CFP — 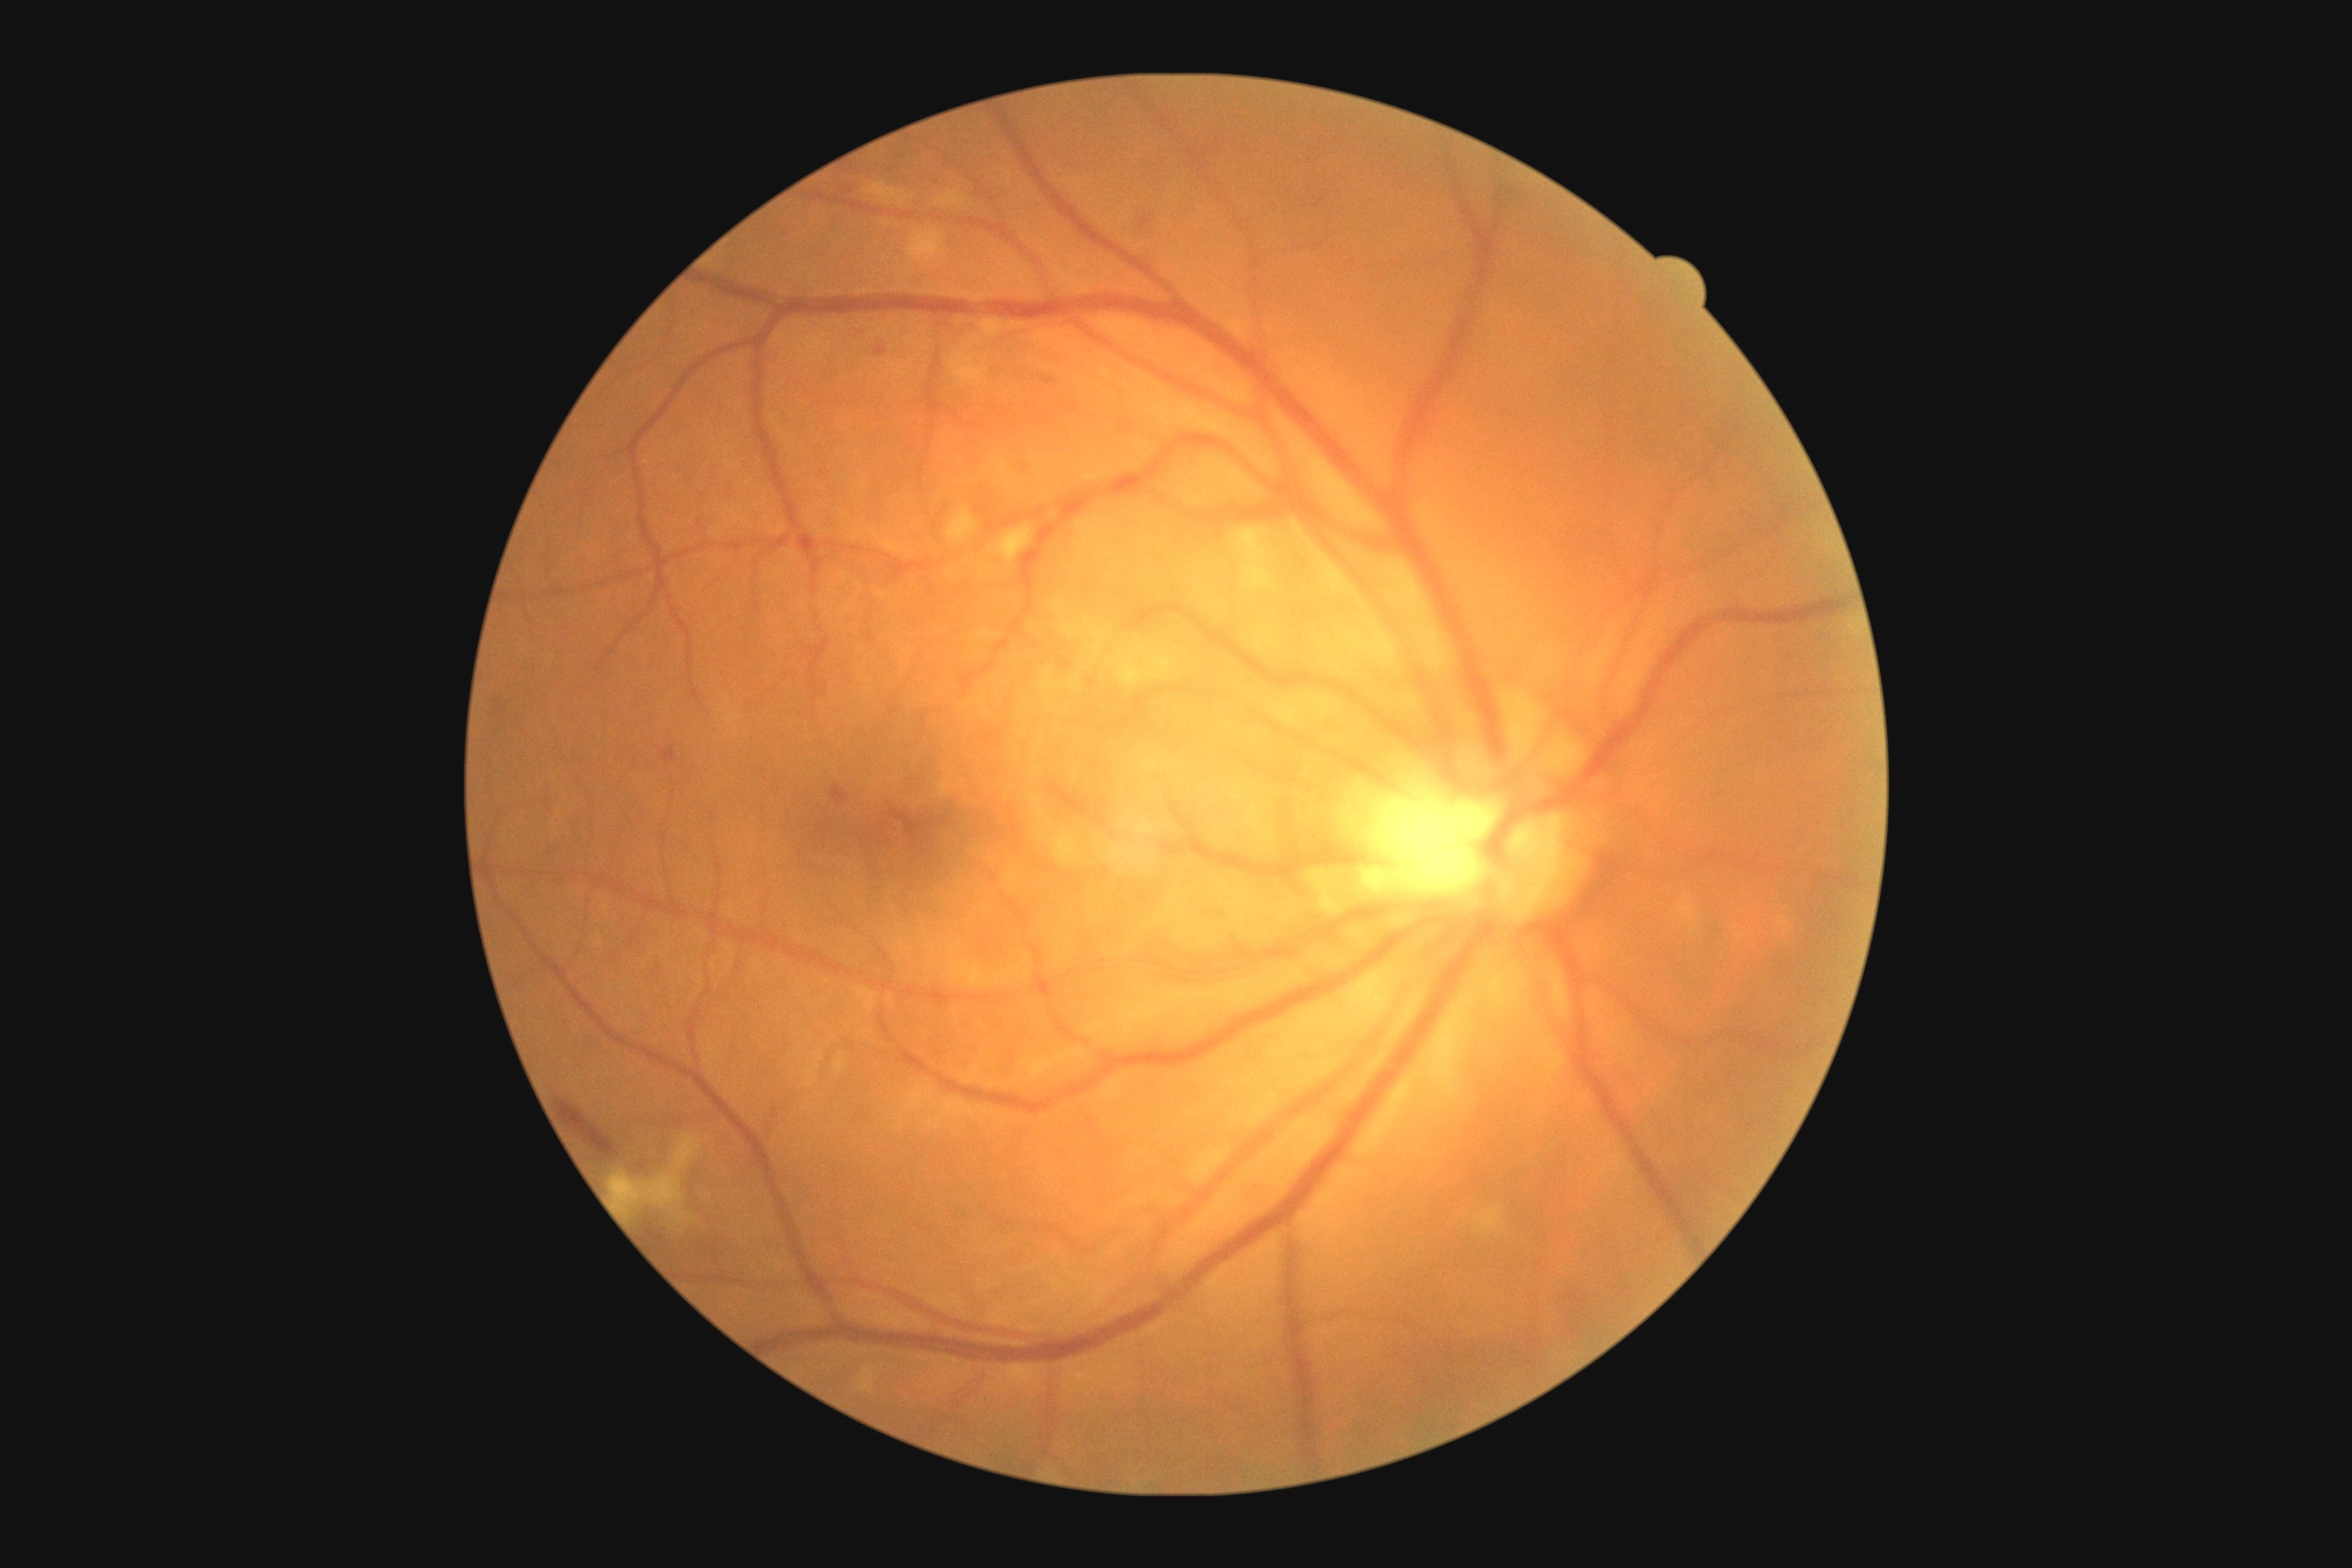 {"dr_grade":2,"lesions":{"se":[[906,230,948,264],[1476,1208,1505,1233],[867,184,908,204],[1008,322,1026,328],[1235,529,1273,589],[941,191,965,210],[676,1208,687,1226],[1052,832,1081,863],[948,353,990,386],[1146,651,1179,676],[859,1369,876,1393],[676,1135,700,1170],[979,320,1004,338],[609,1171,683,1213],[1119,658,1152,685],[948,509,977,544],[990,527,1032,564]],"se_small":[[1140,648],[1160,677],[1136,655]],"ma":[[830,787,848,805],[662,747,676,763],[1043,375,1055,384],[1121,420,1133,433],[876,348,887,357]],"ma_small":[[1092,683],[1066,665]],"he":[[1137,210,1161,244],[558,1102,616,1159]],"ex":null}}